2212x1659. Color fundus image — 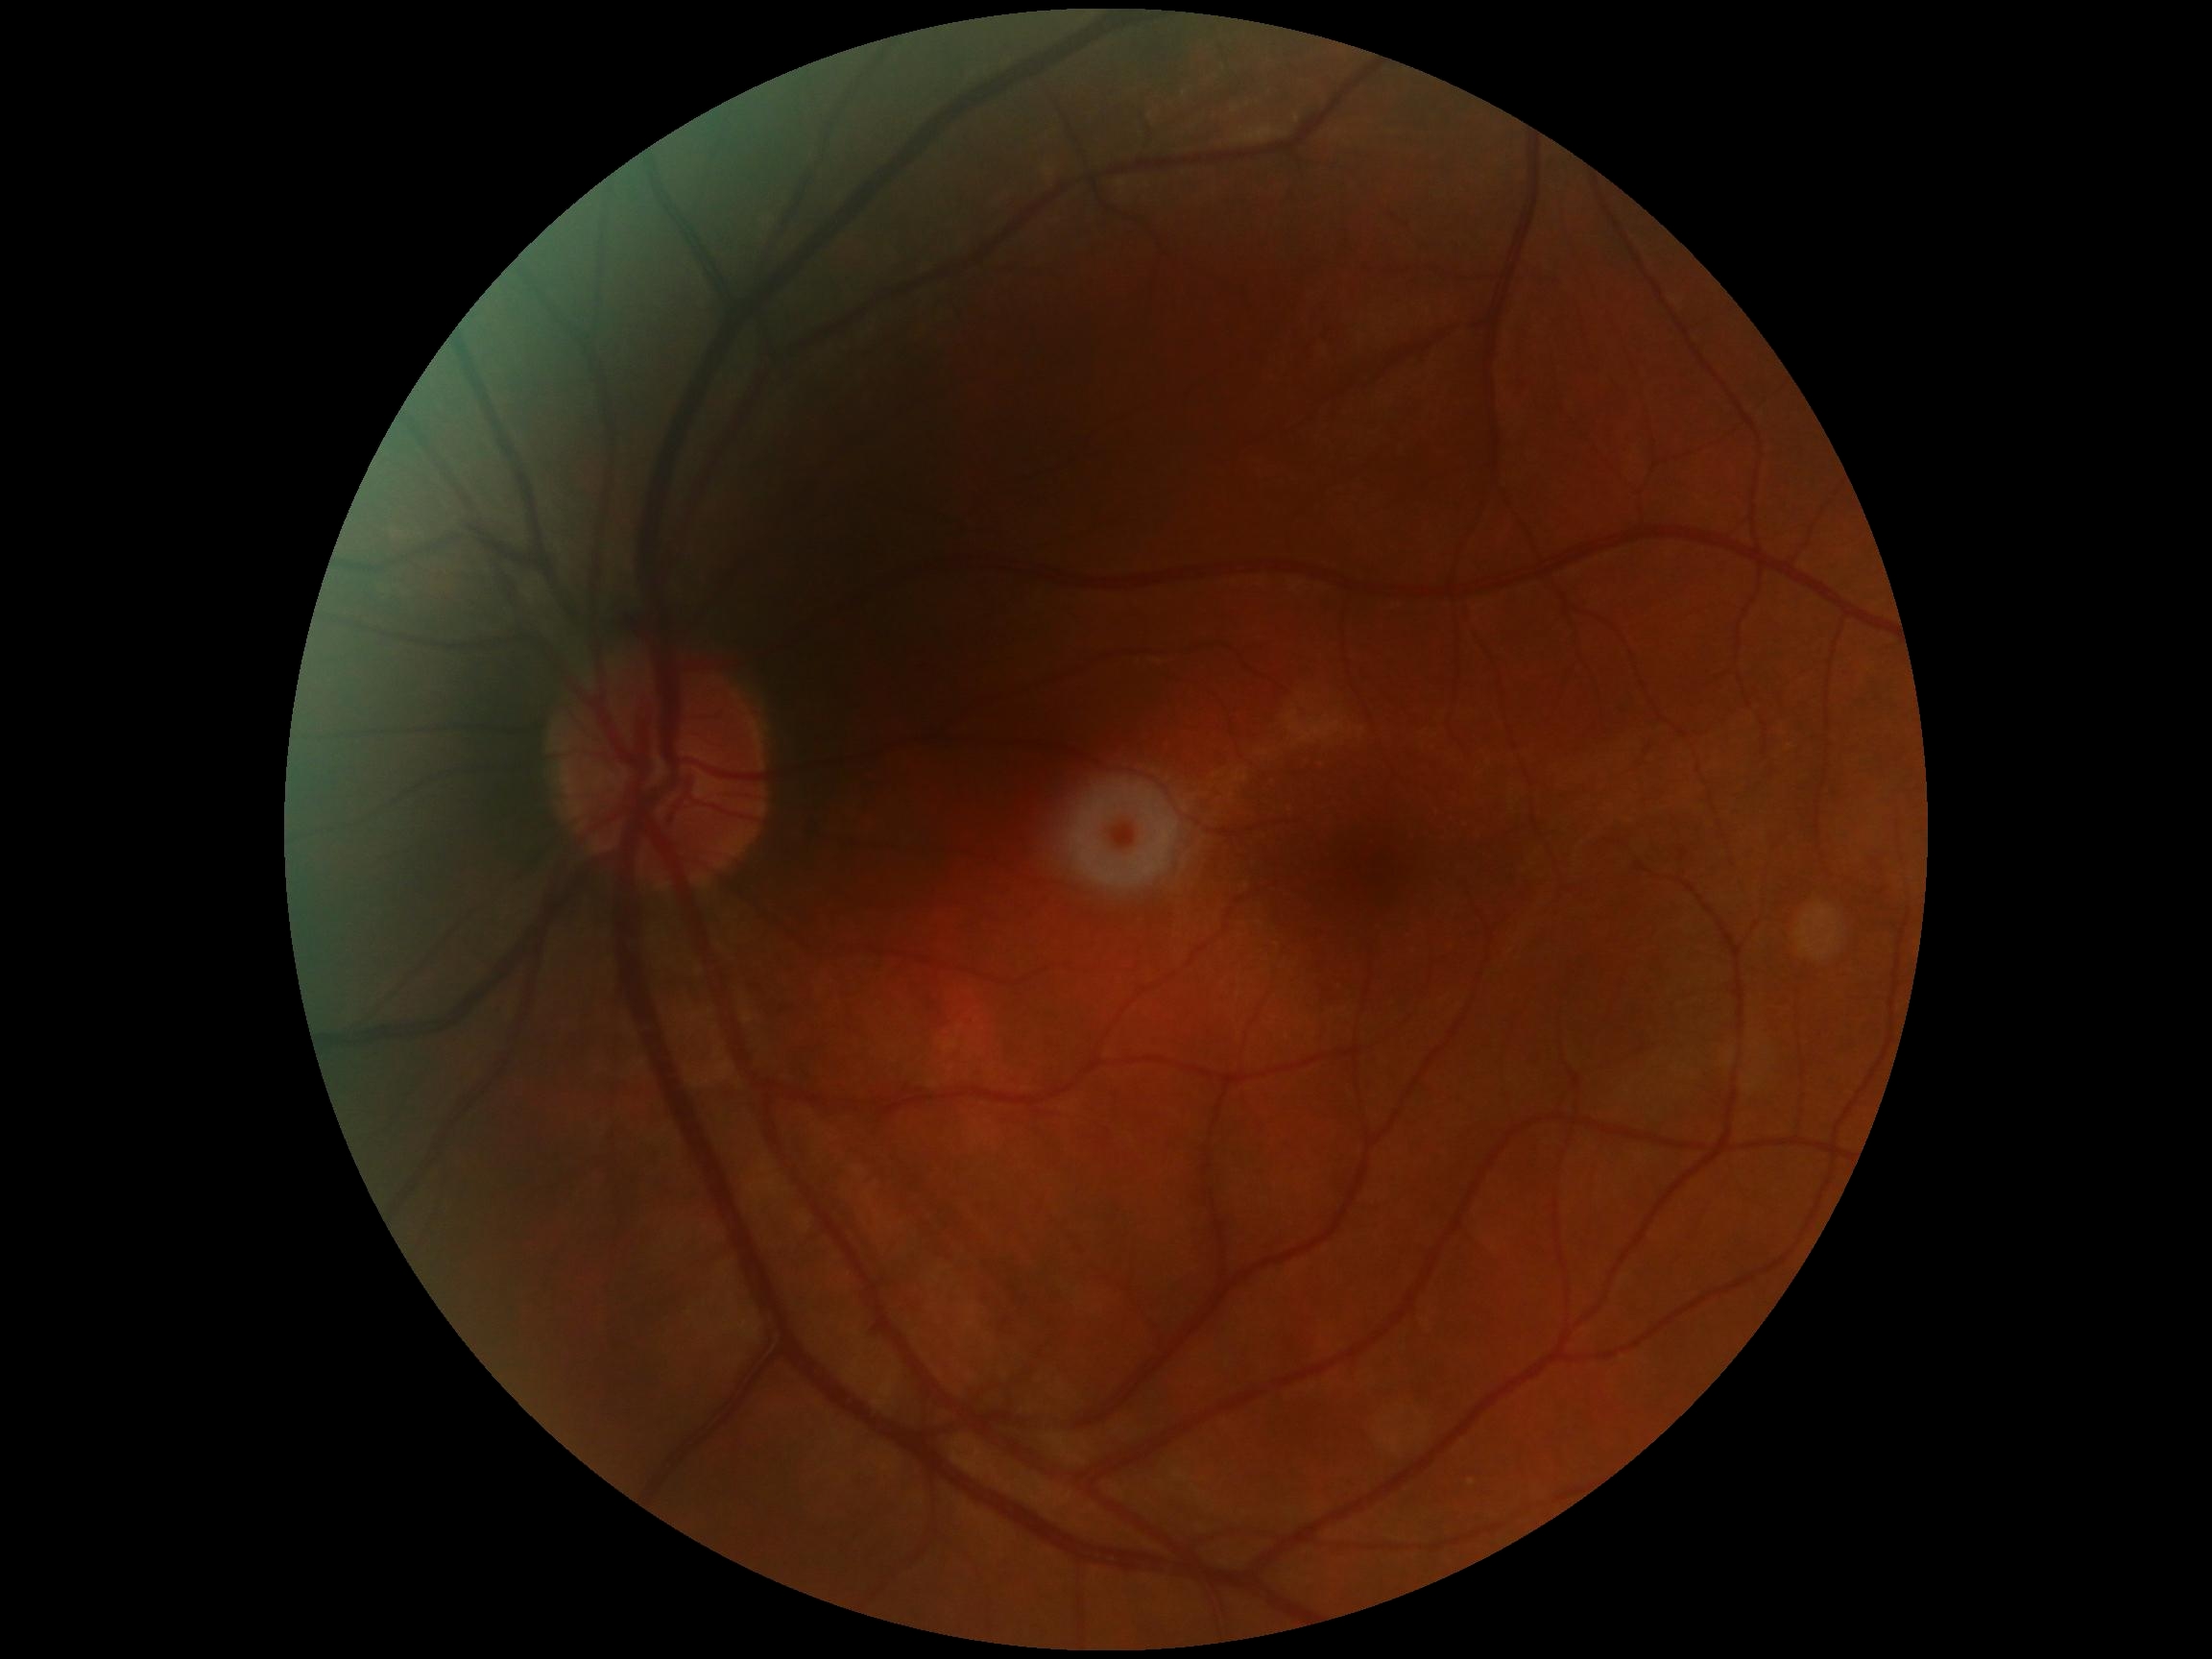

Diabetic retinopathy (DR): grade 0 (no apparent retinopathy).